Mydriatic (tropicamide and phenylephrine):
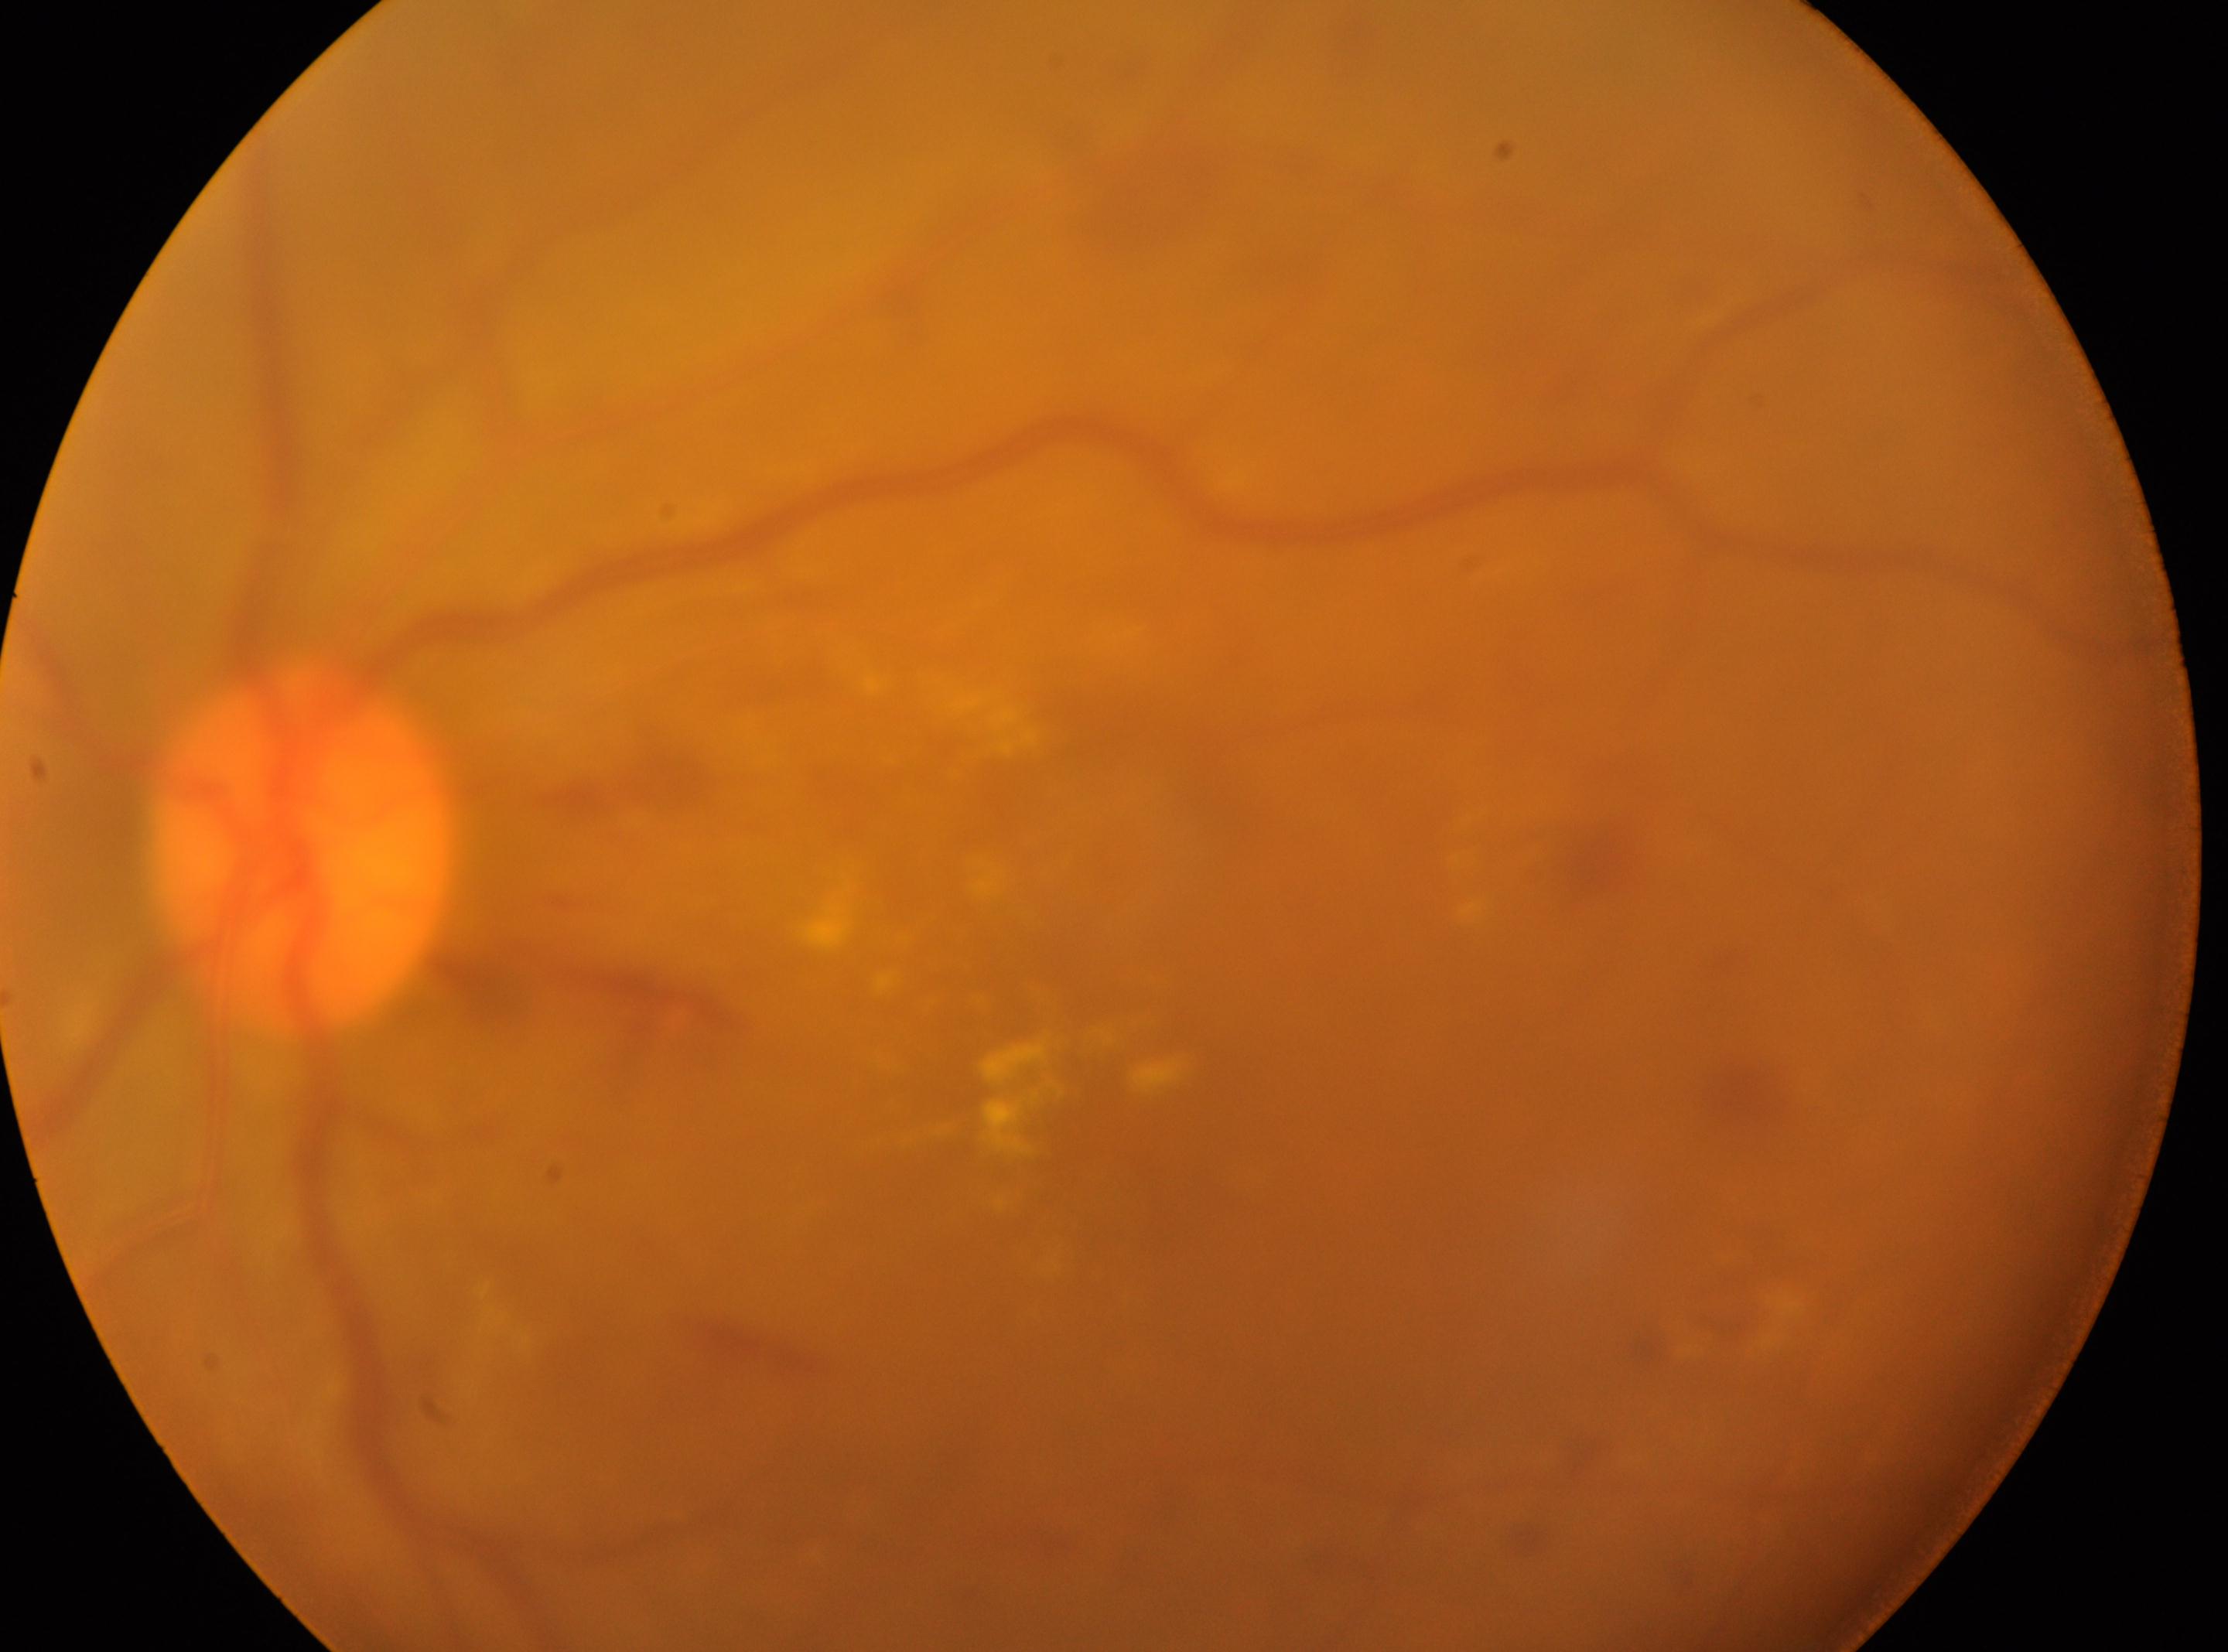
Optic disk: (299,848). The fovea centralis is at (1123,1142). Retinopathy is 2. The image shows the left eye.